Wide-field fundus image from infant ROP screening.
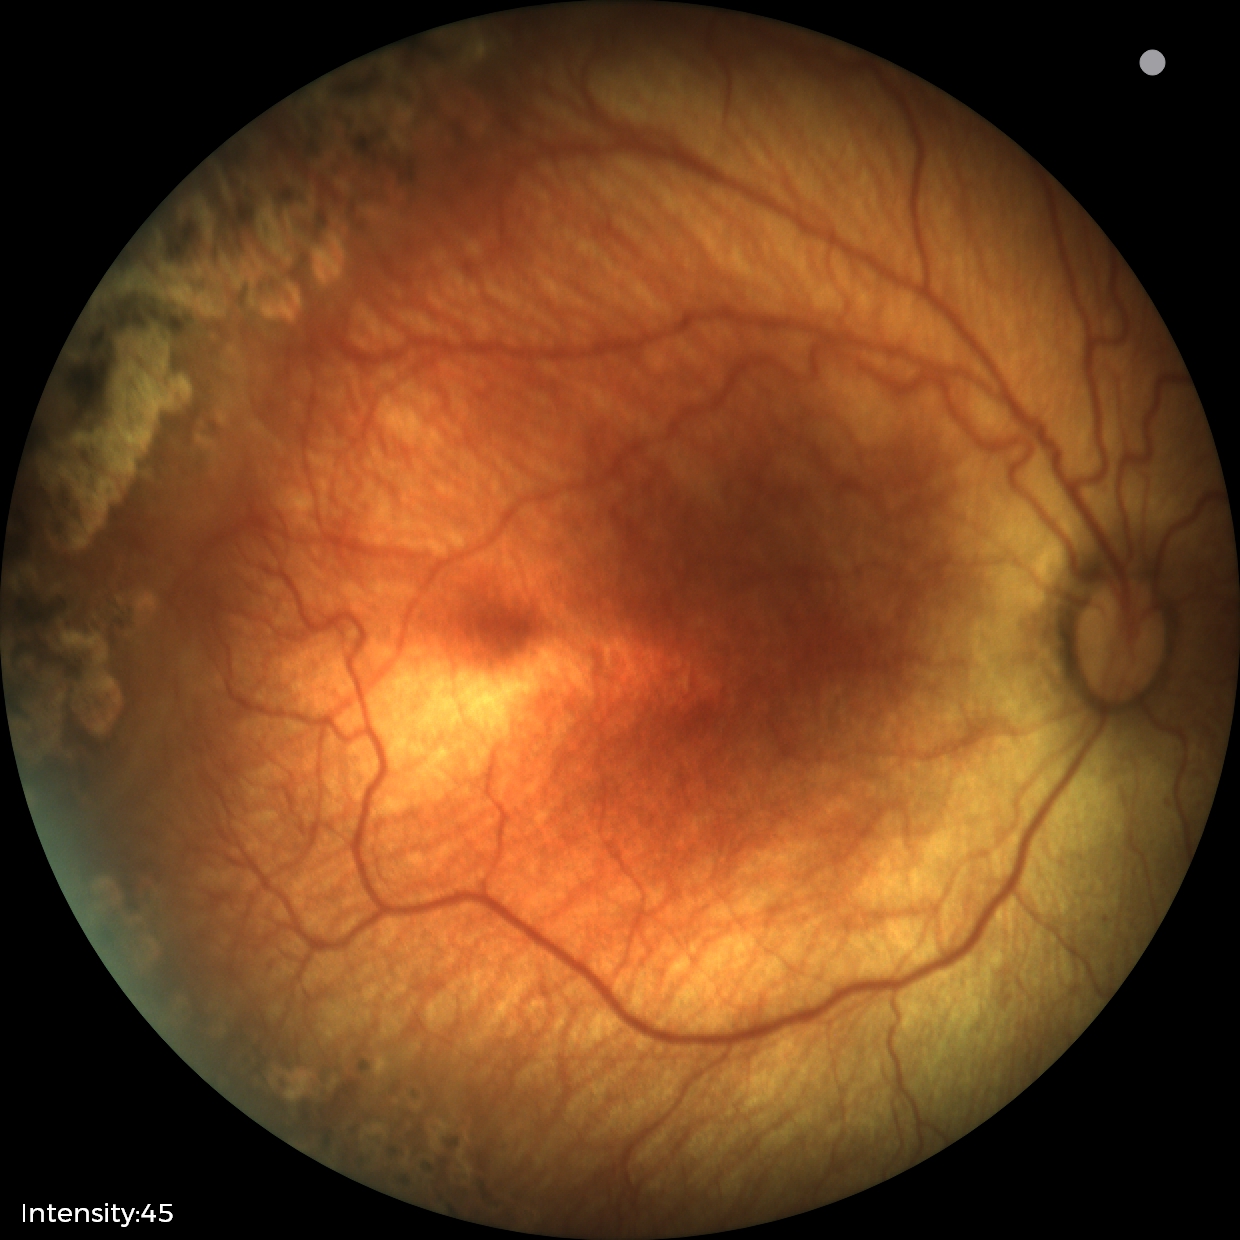
Plus form: absent; finding: status post retinopathy of prematurity — retinal appearance after treated retinopathy of prematurity.